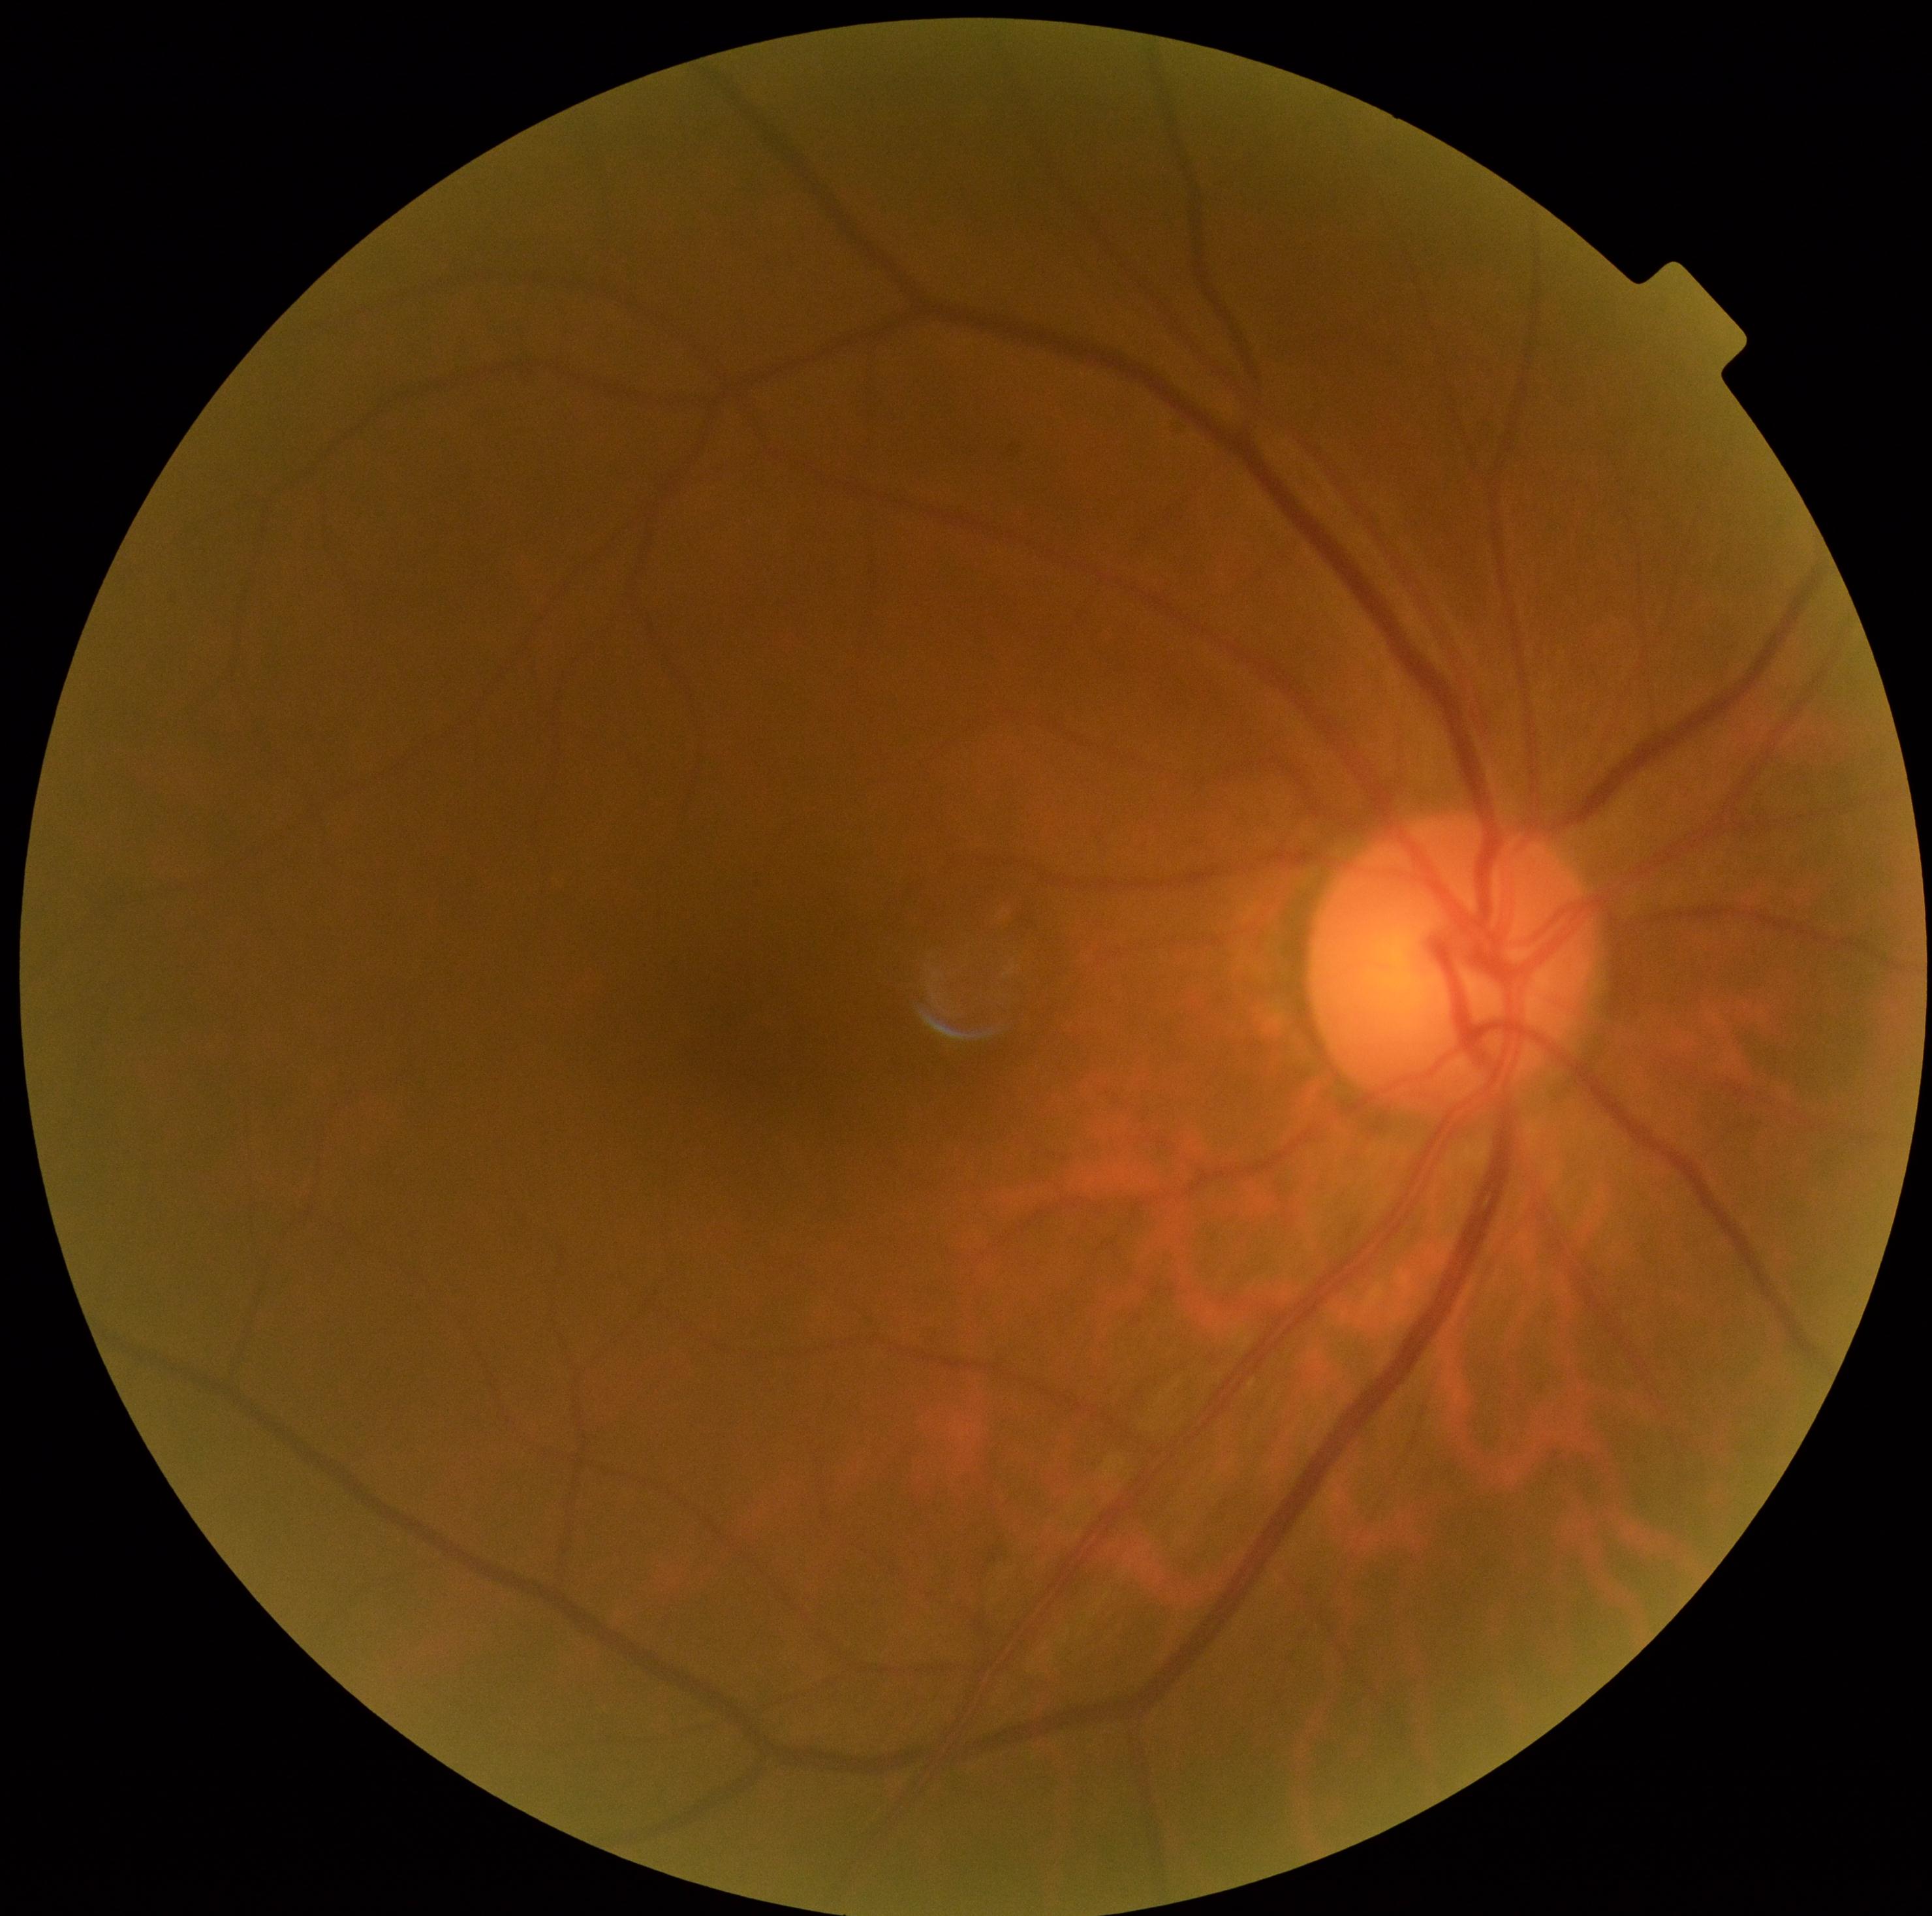
DR severity is grade 0.